2352 x 1568 pixels:
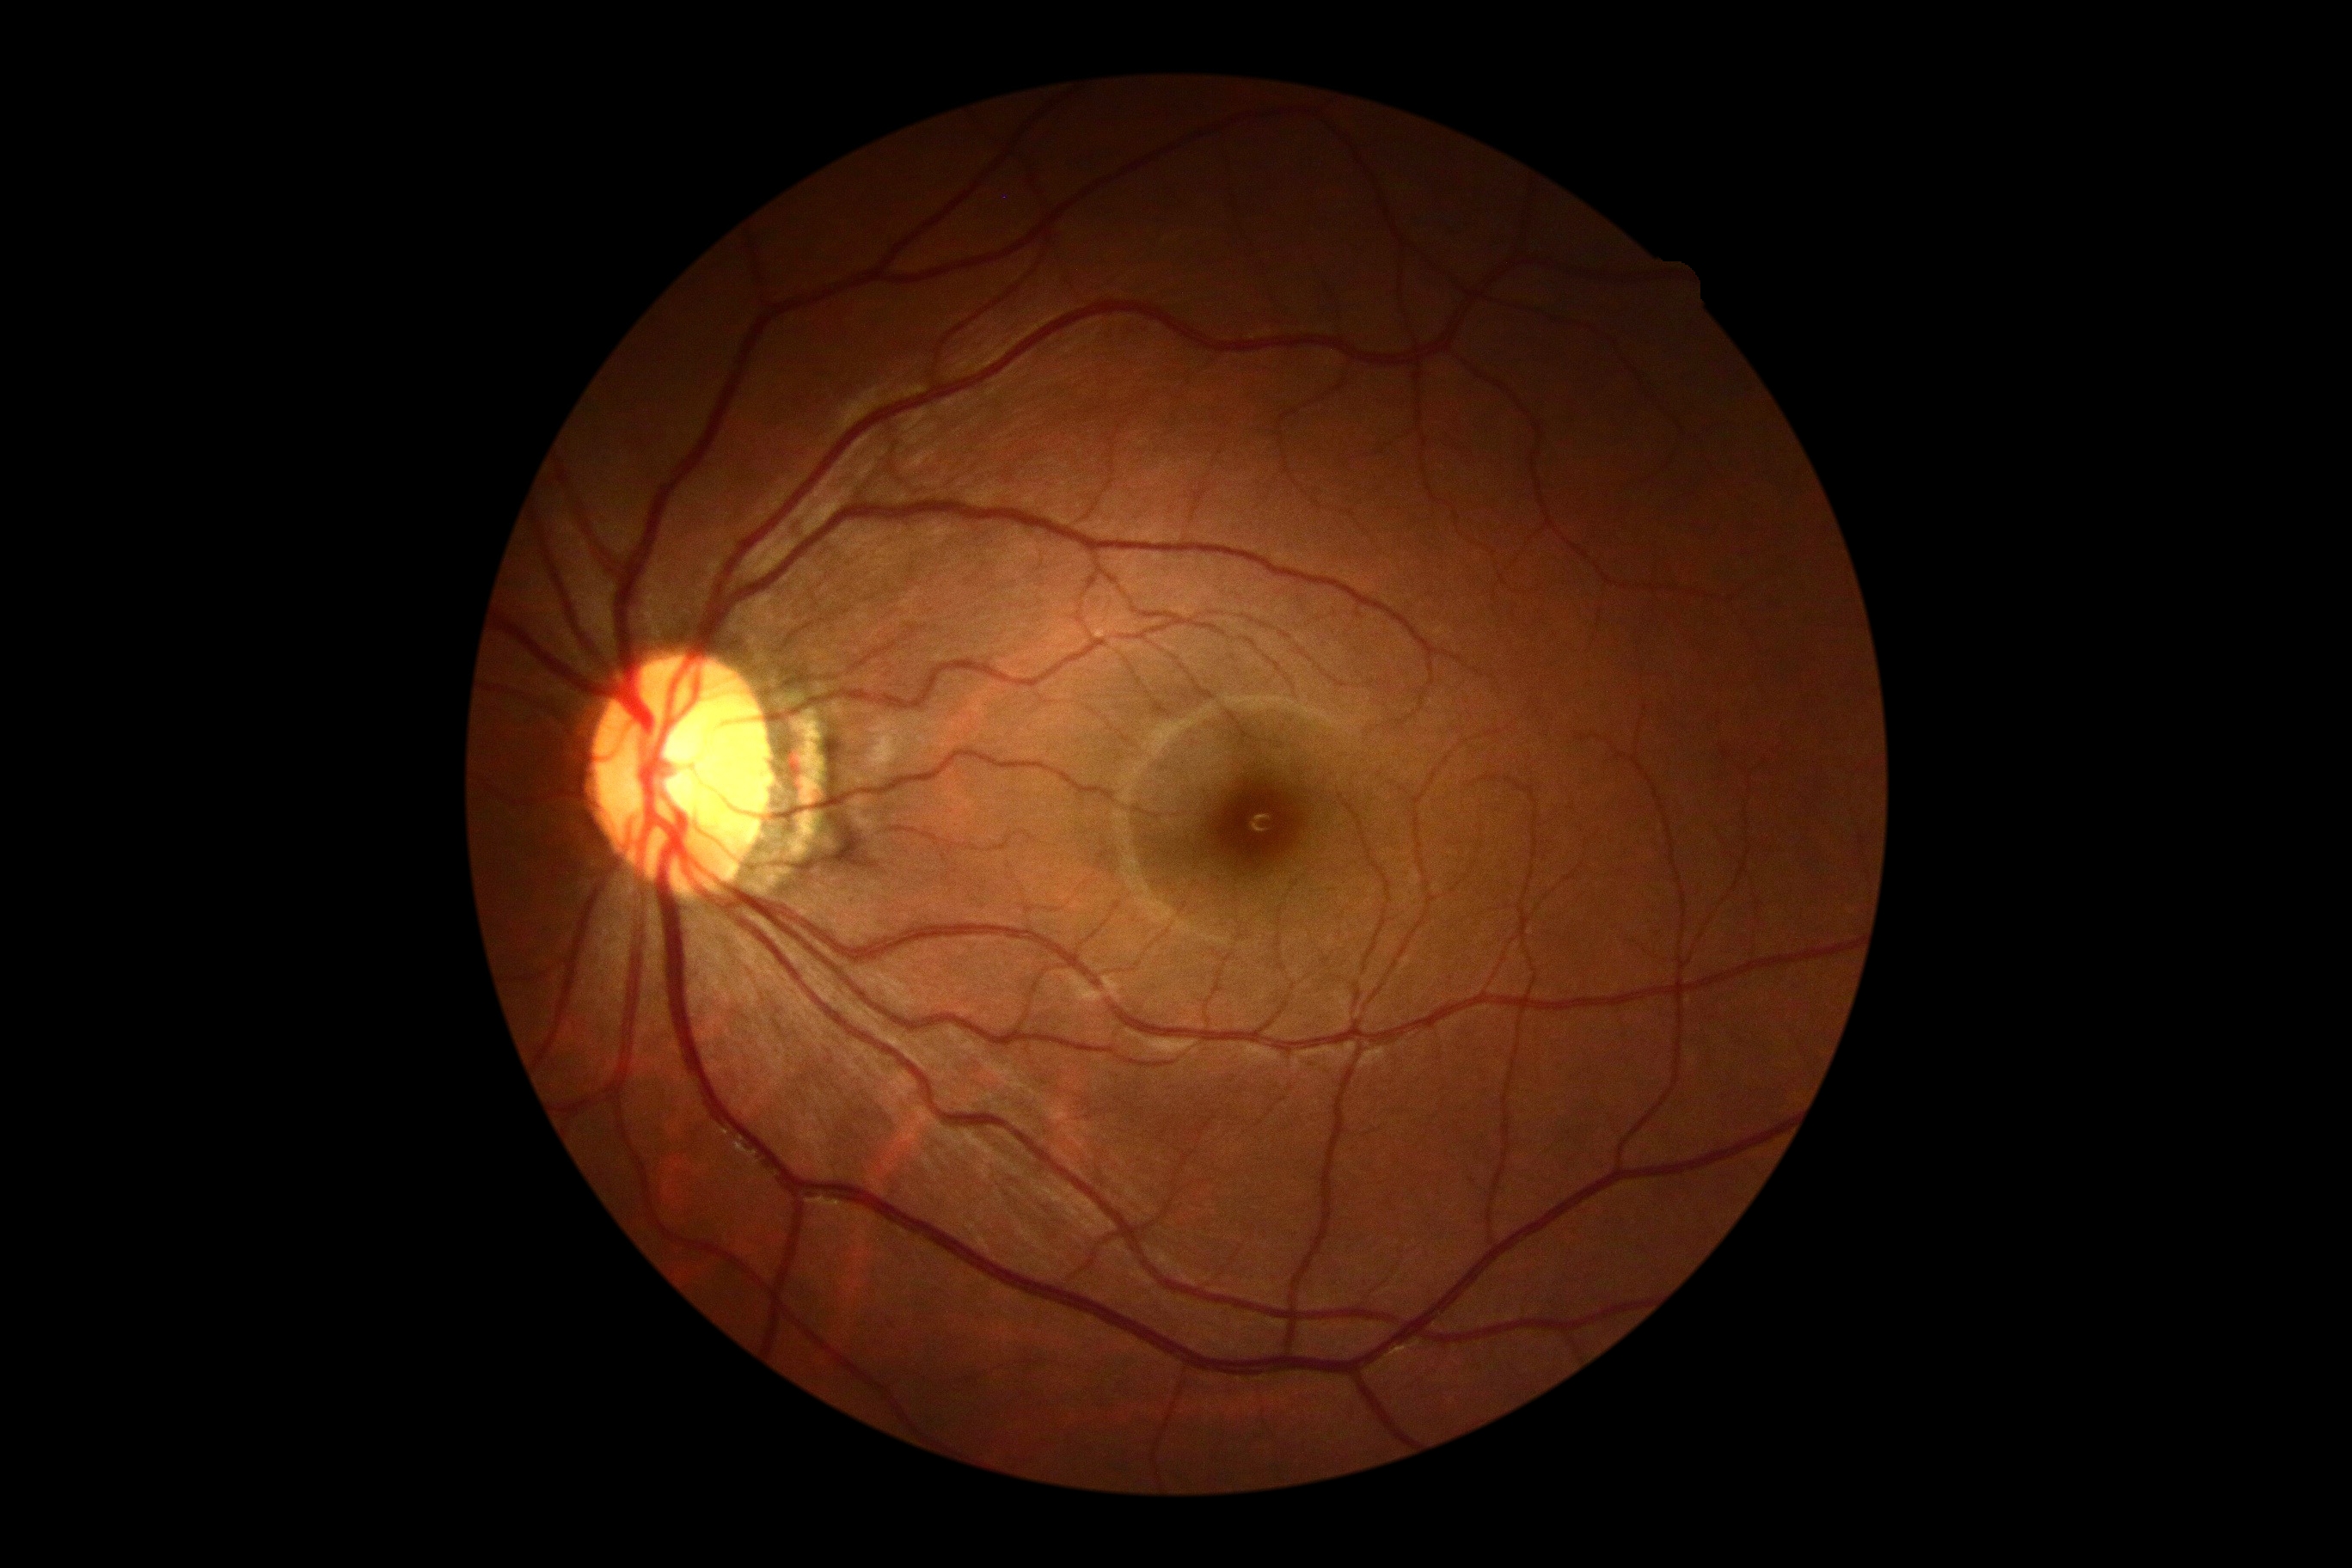 Diabetic retinopathy grade: 0.